2352 x 1568 pixels — 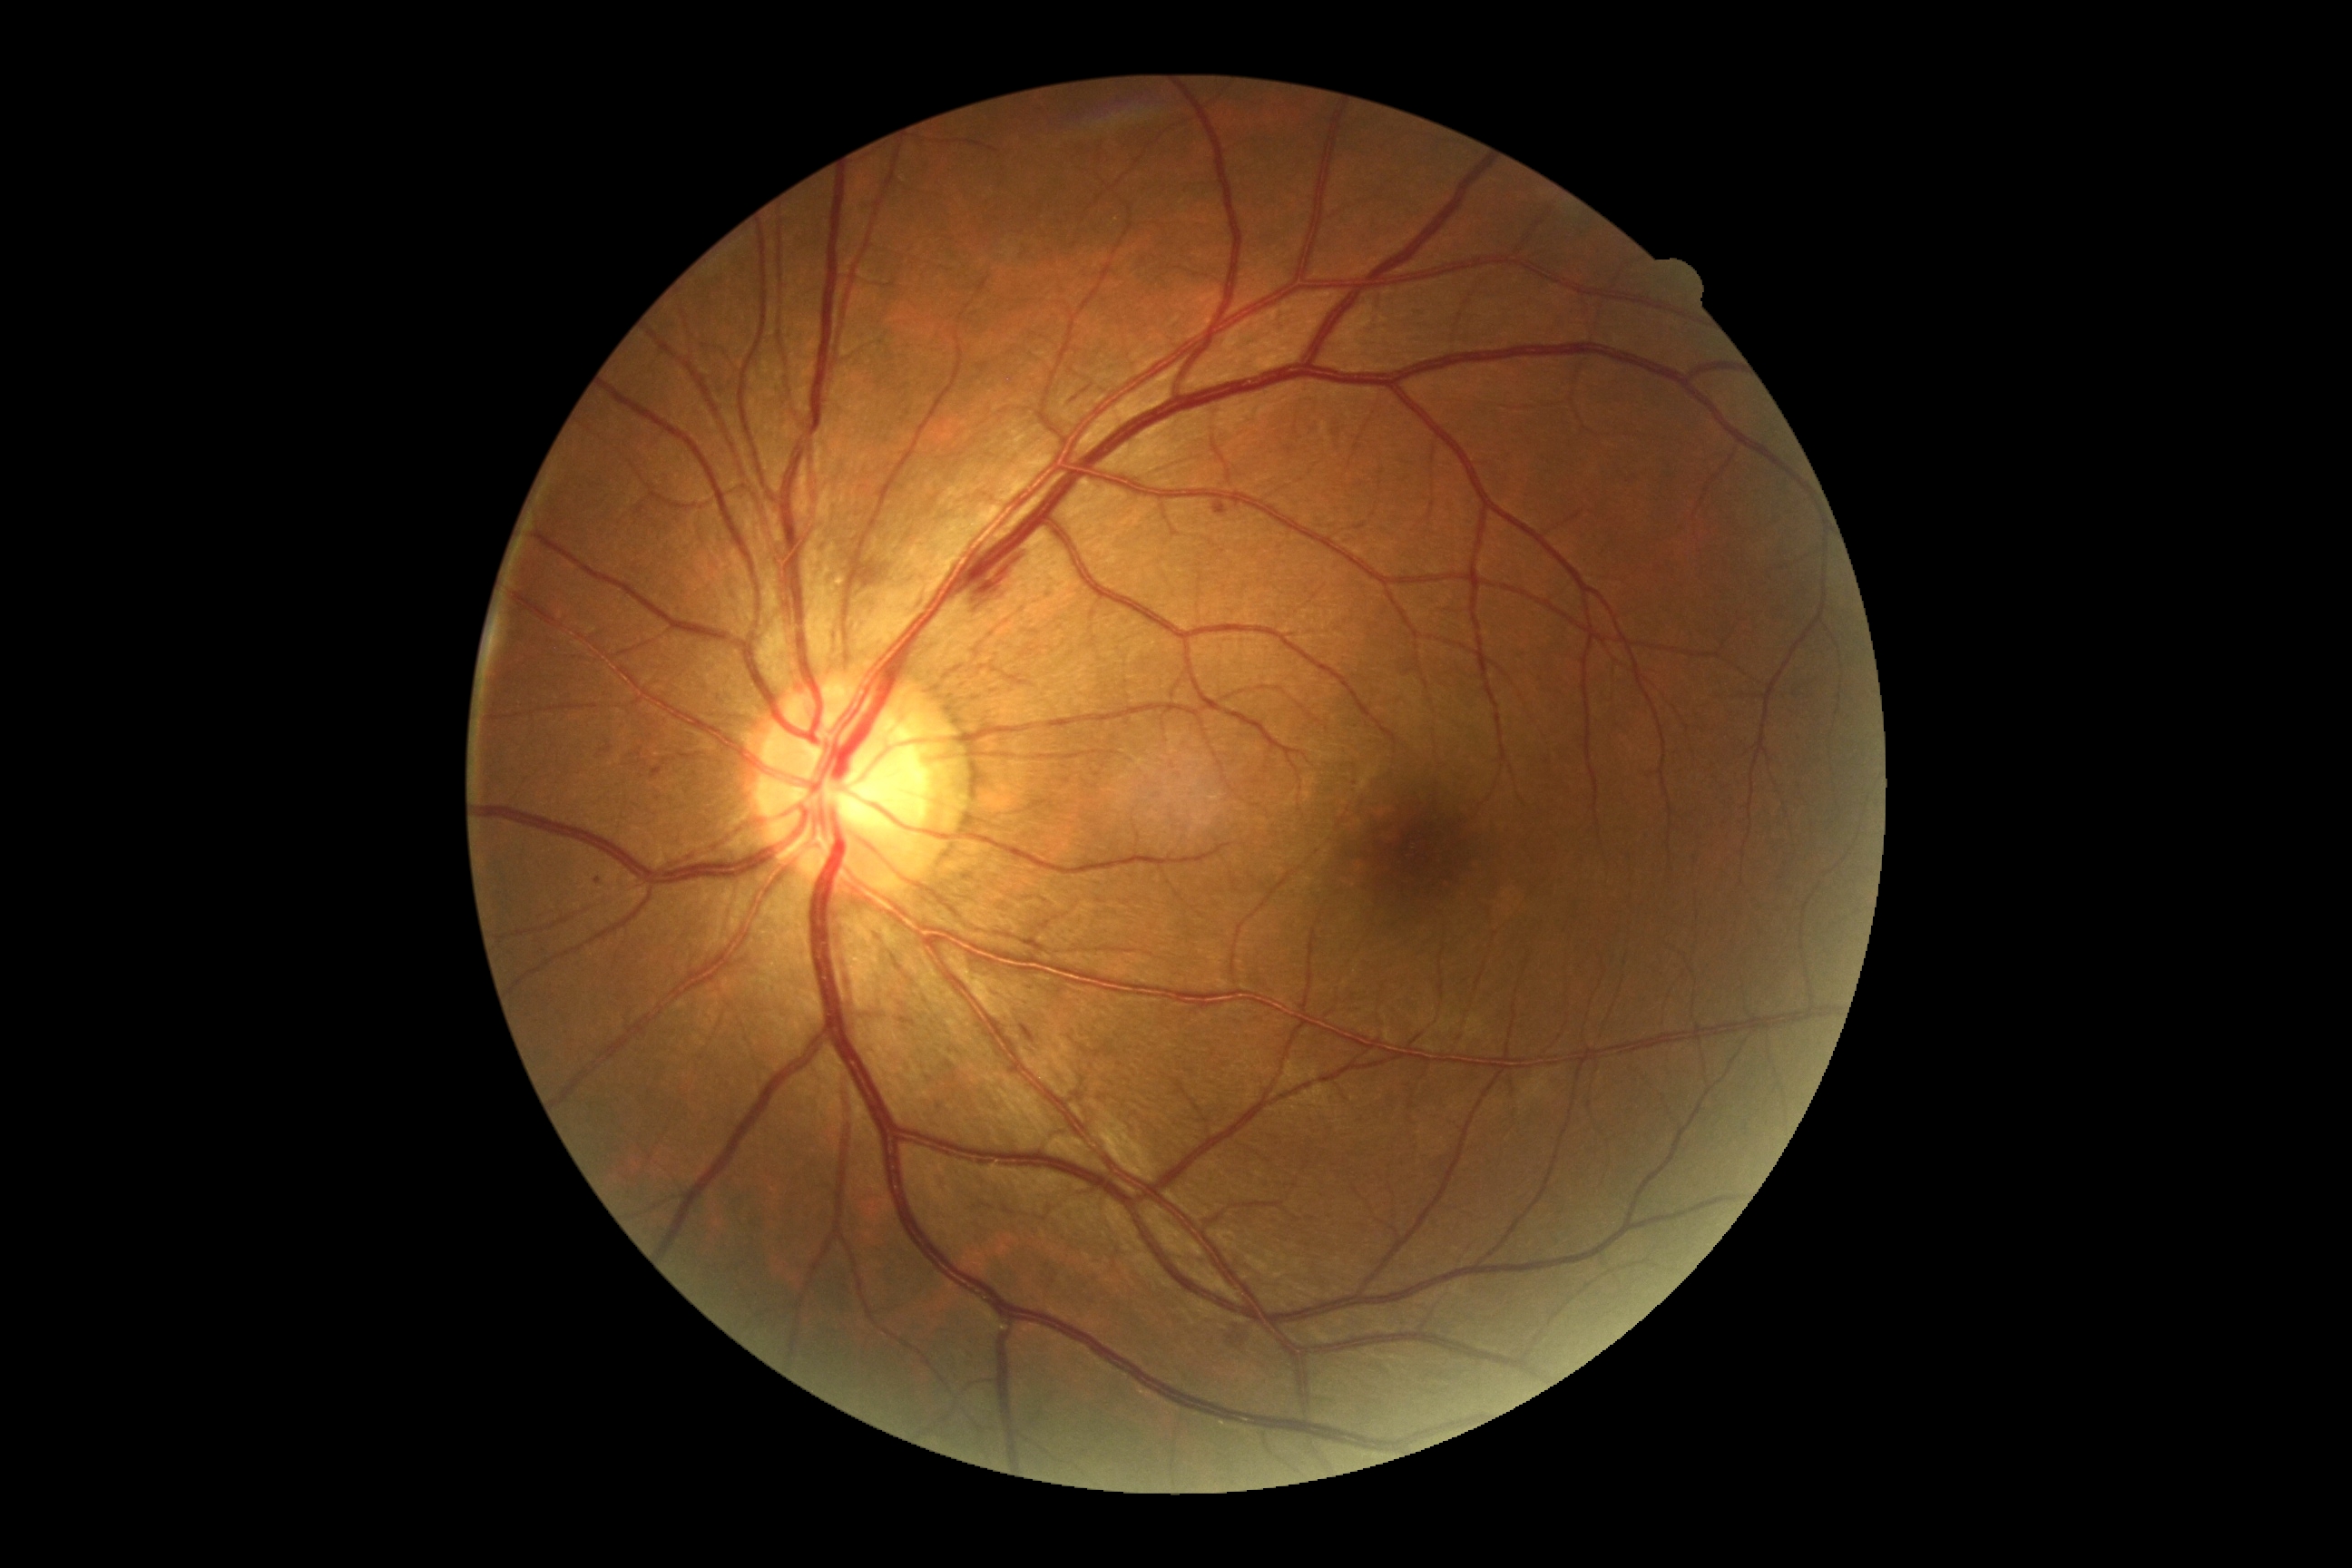
{"dr_category": "non-proliferative diabetic retinopathy", "dr_grade": "moderate non-proliferative diabetic retinopathy (2)"}